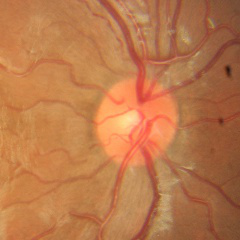 No glaucomatous changes.